848x848px — 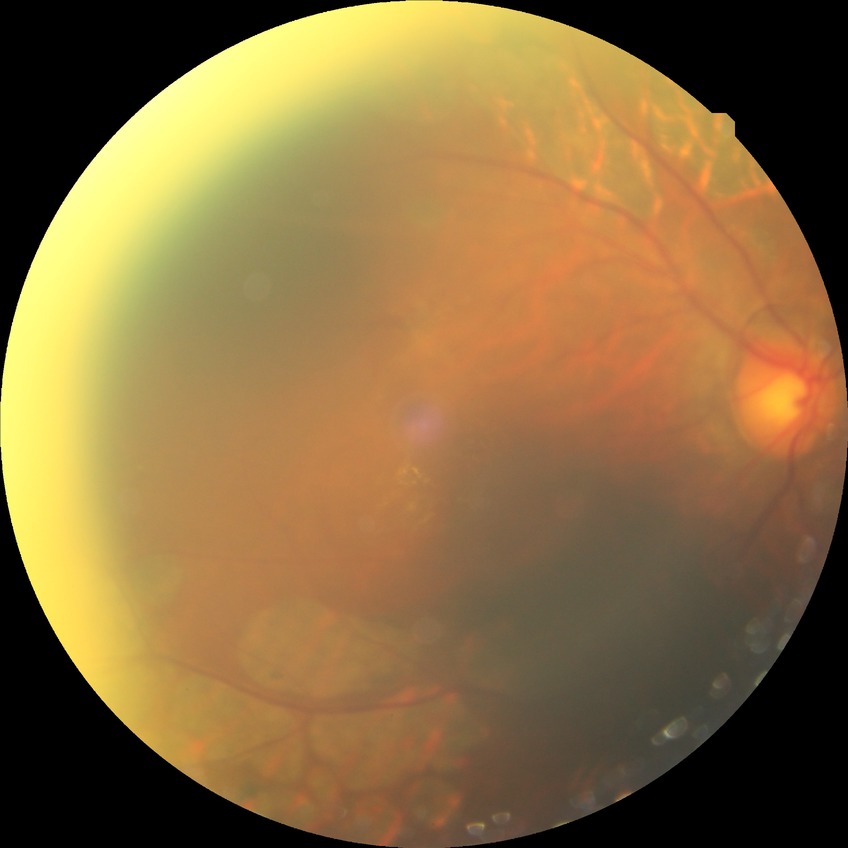 Diabetic retinopathy (DR) is PDR (proliferative diabetic retinopathy).